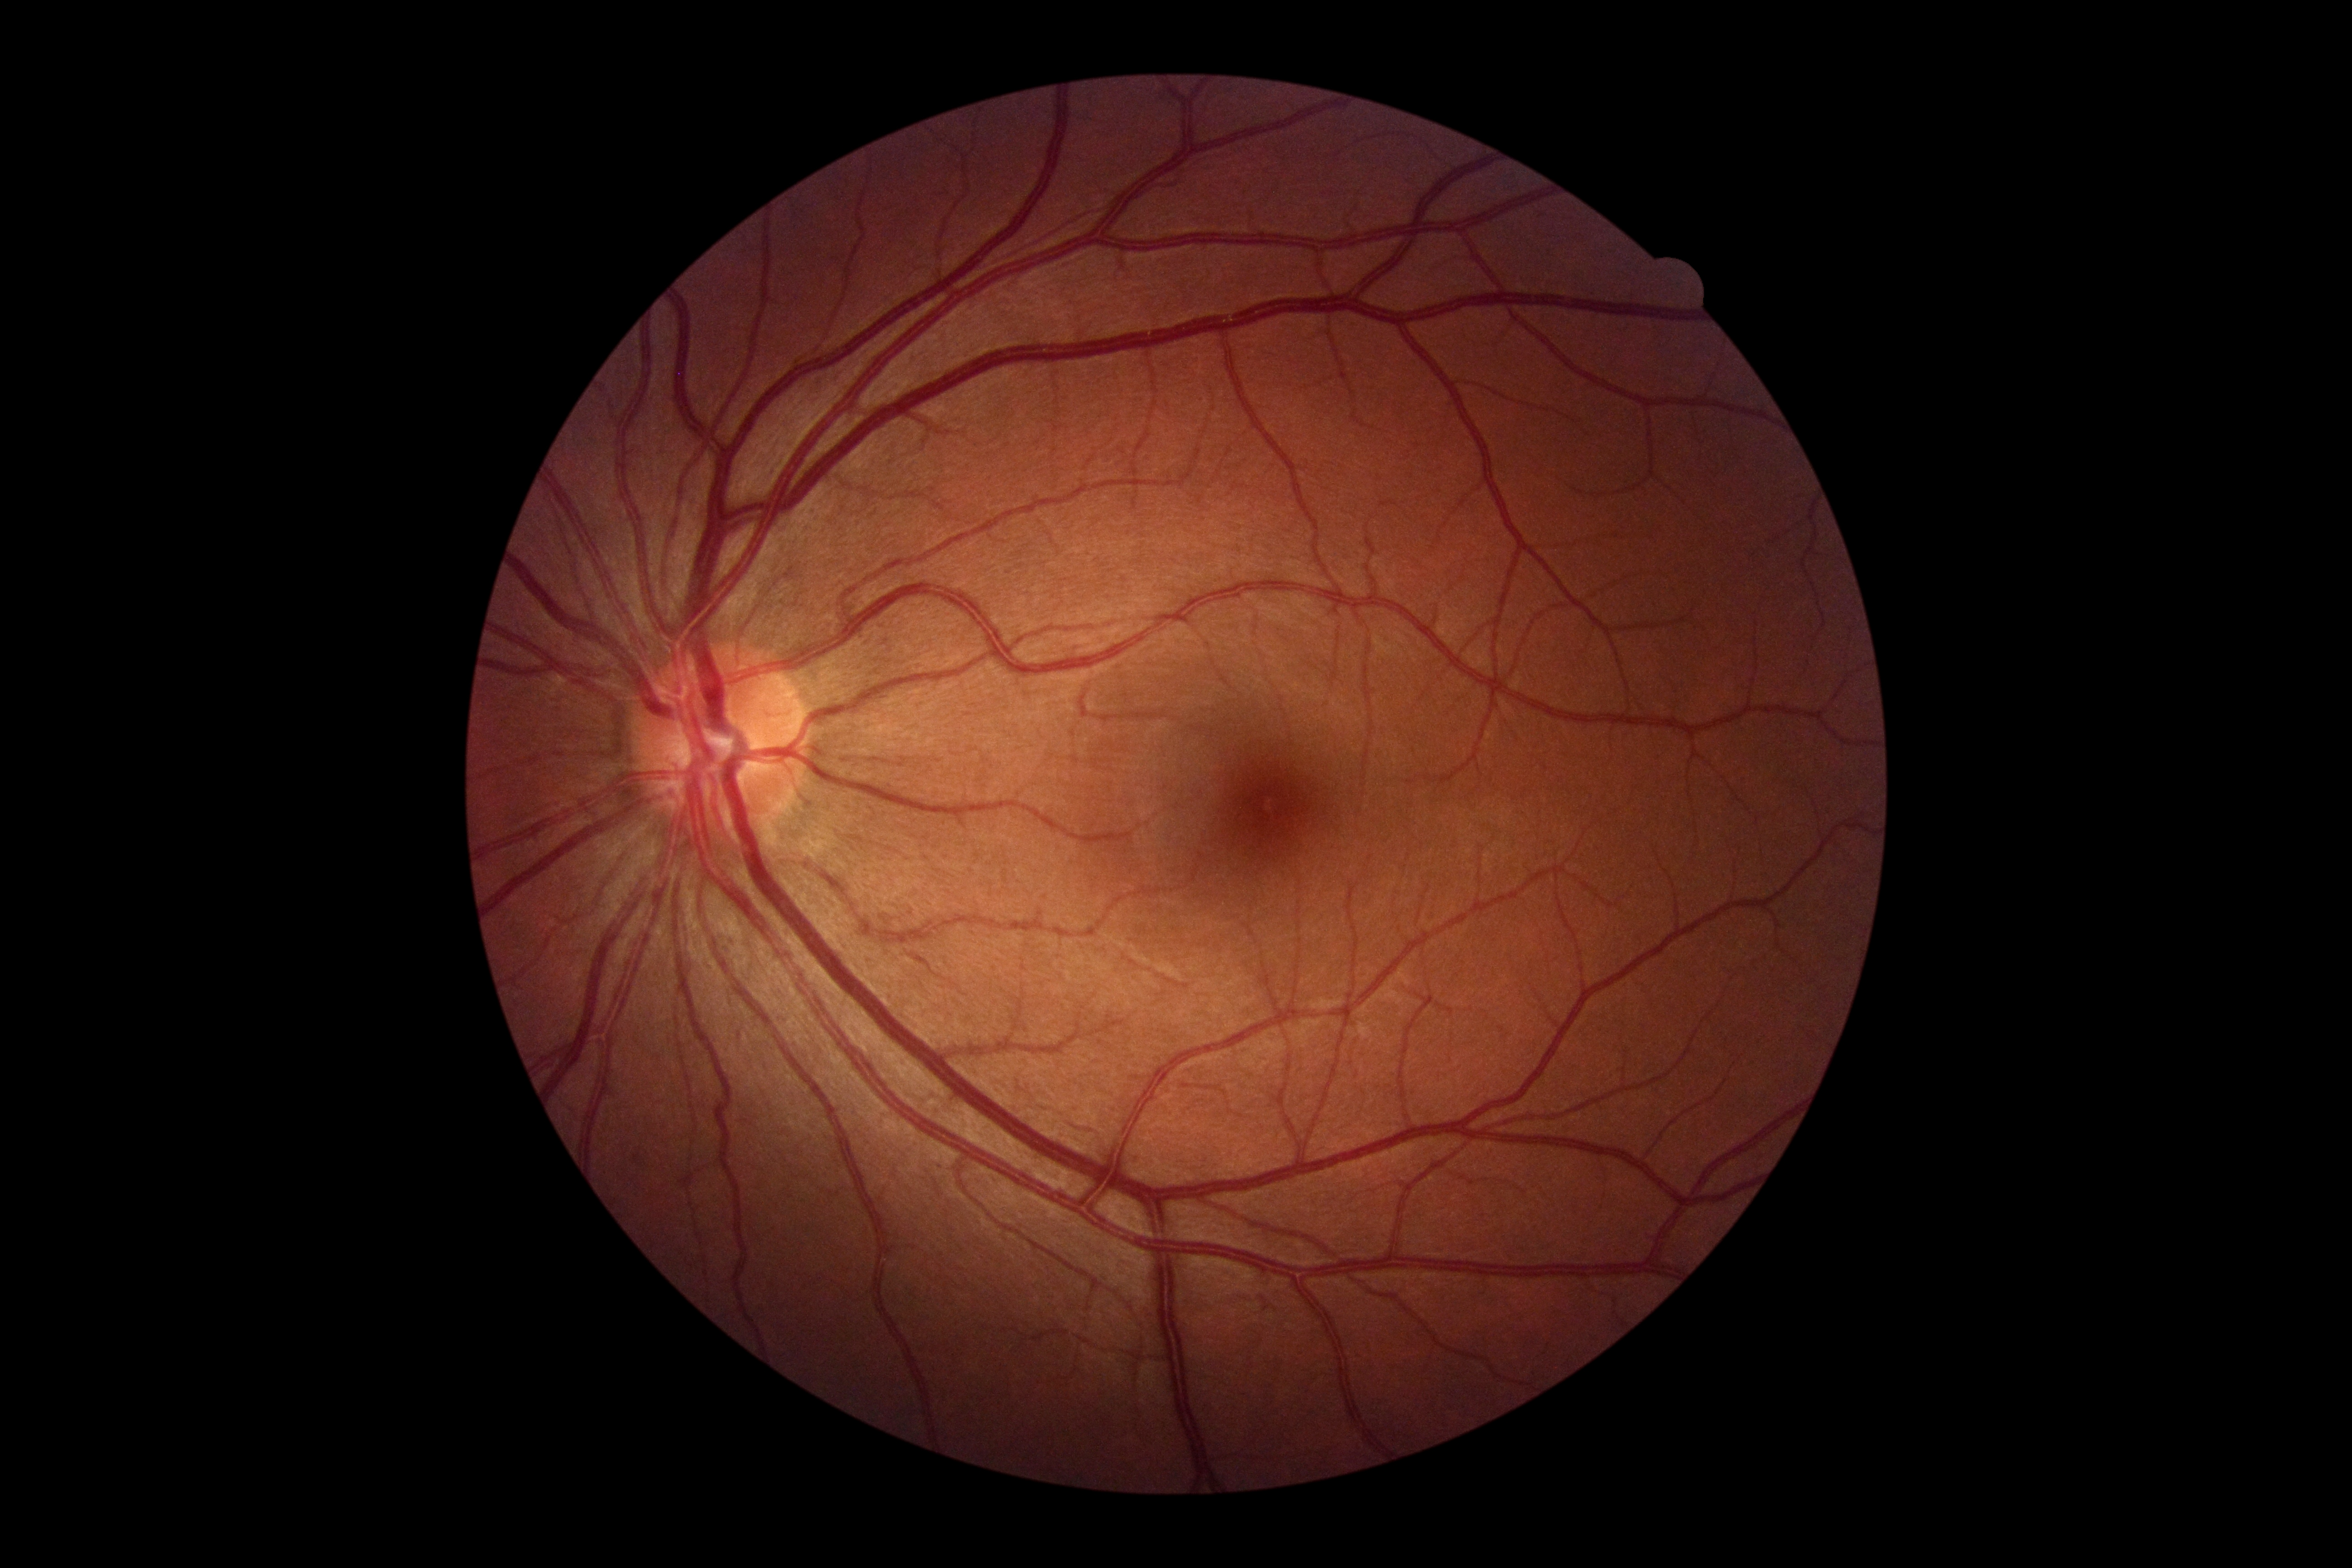 Diabetic retinopathy grade: 0 (no apparent retinopathy). No DR findings.